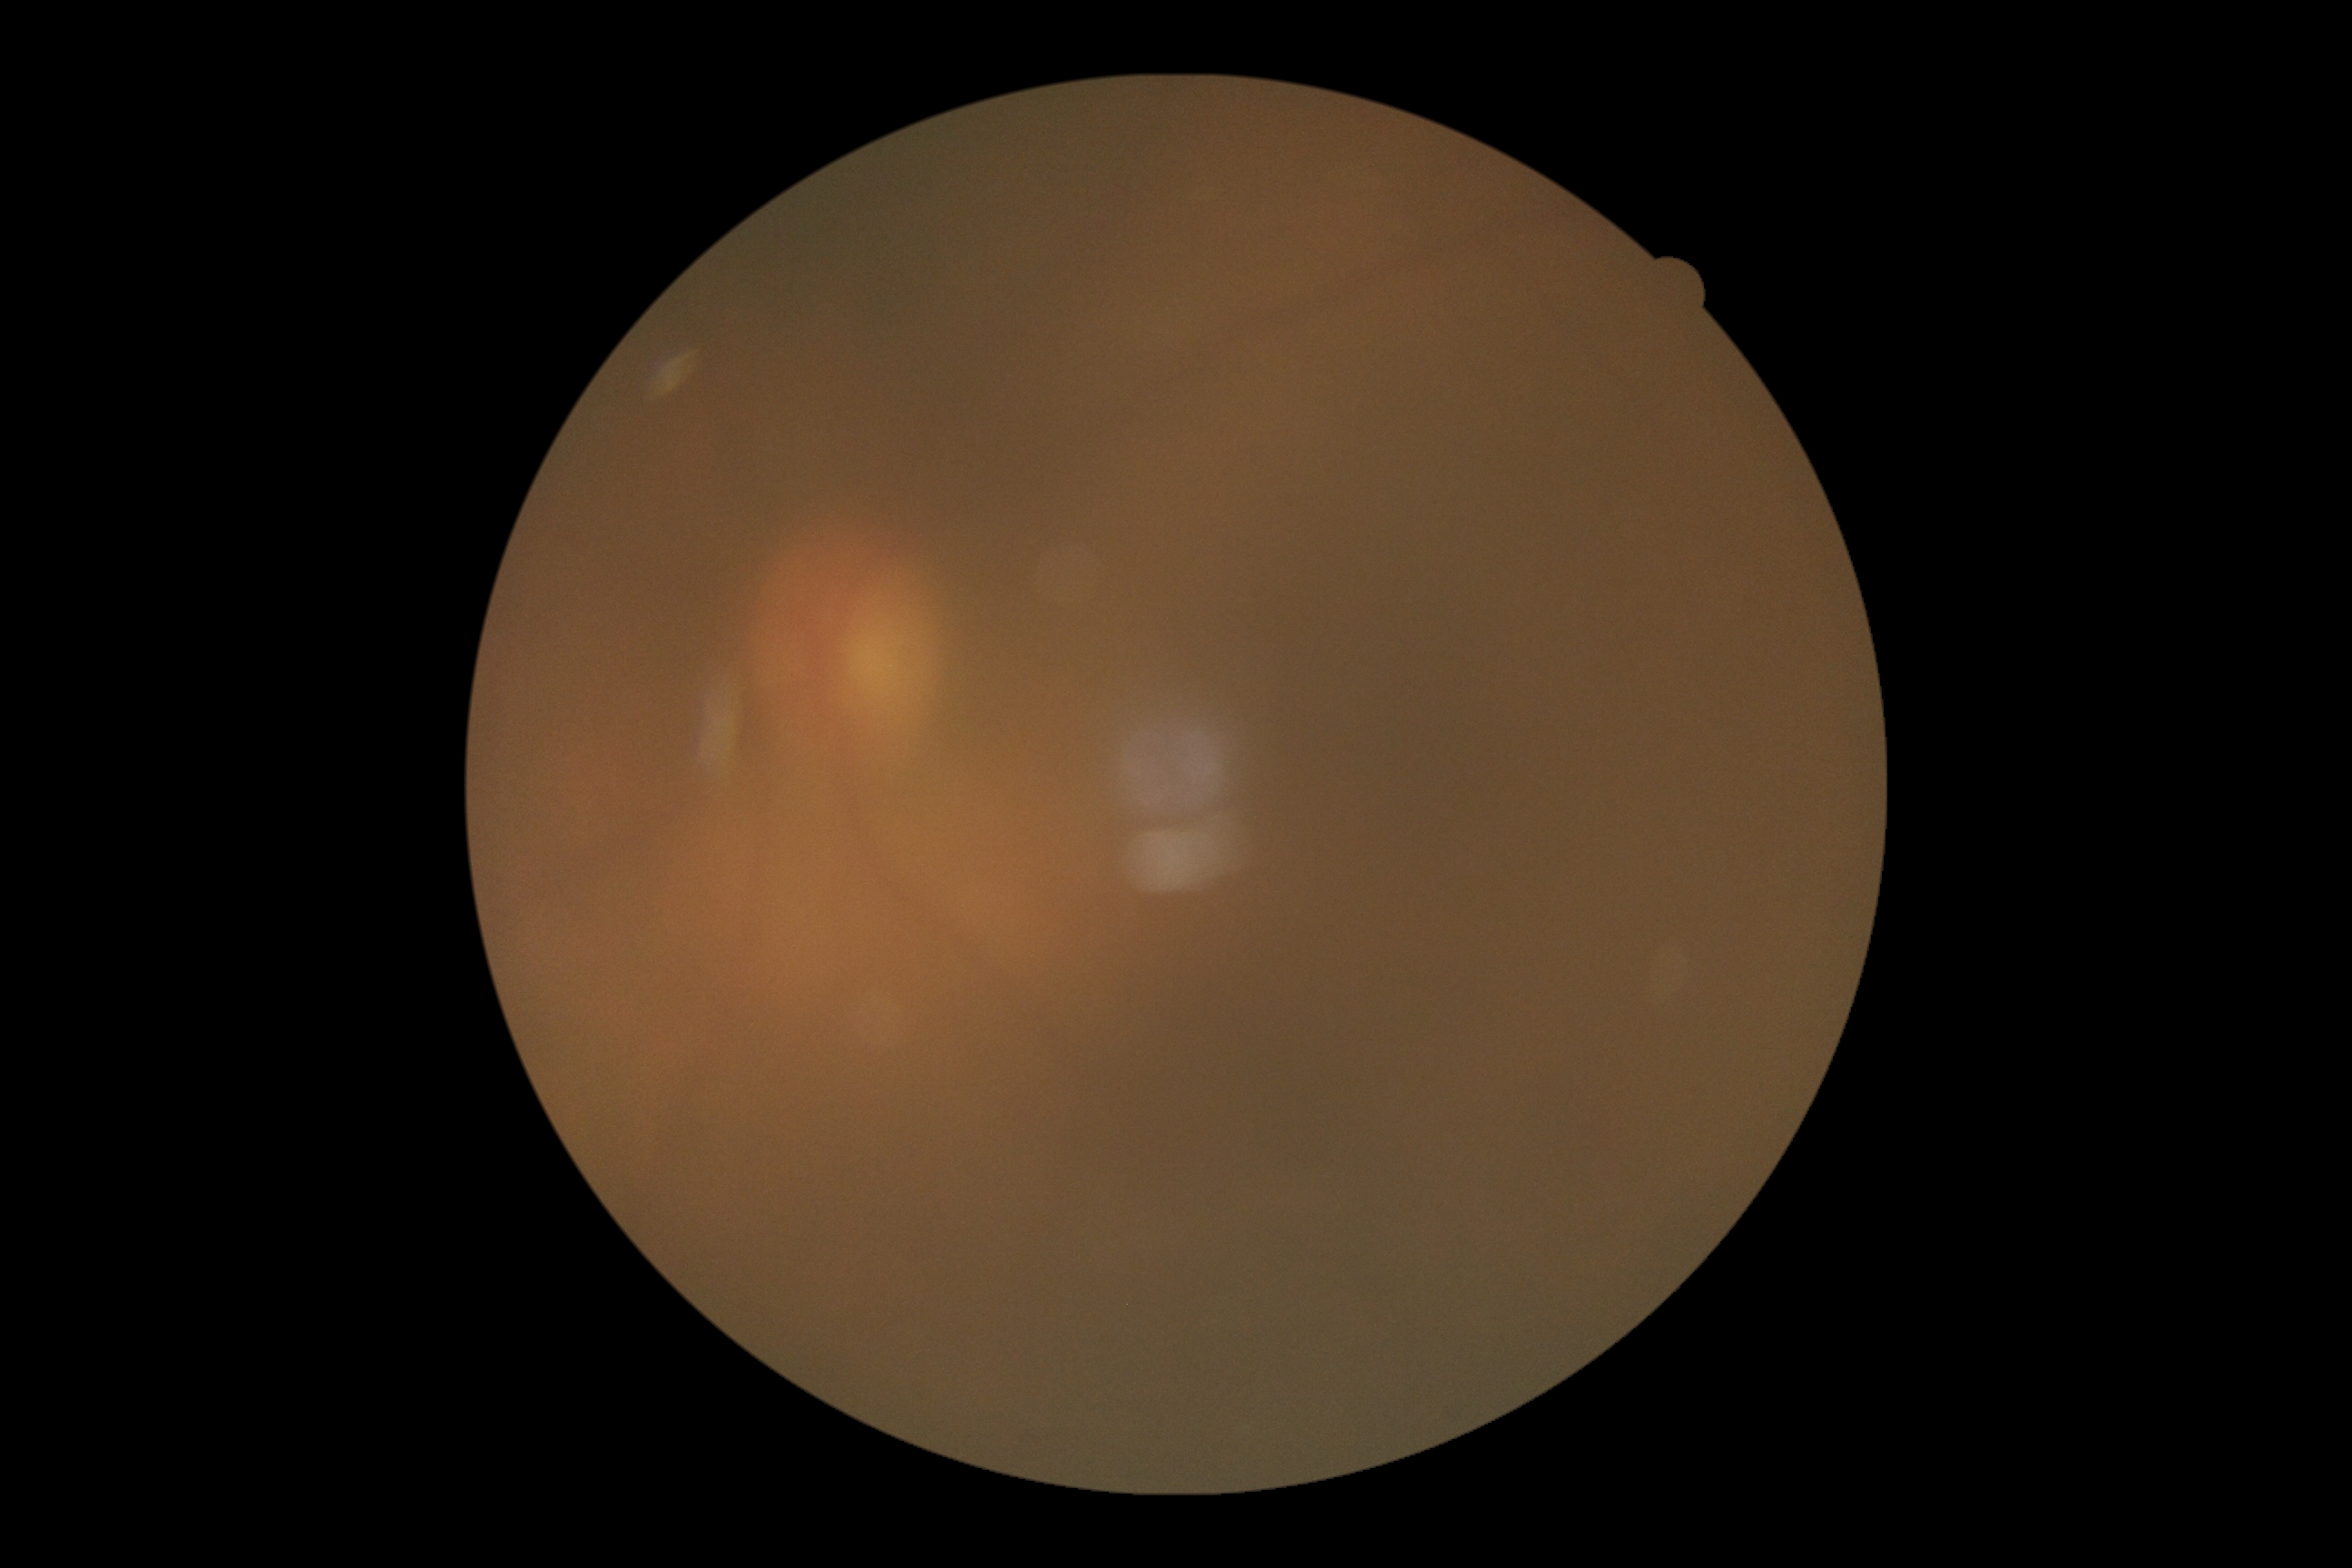
Retinopathy grade is ungradable due to poor image quality.